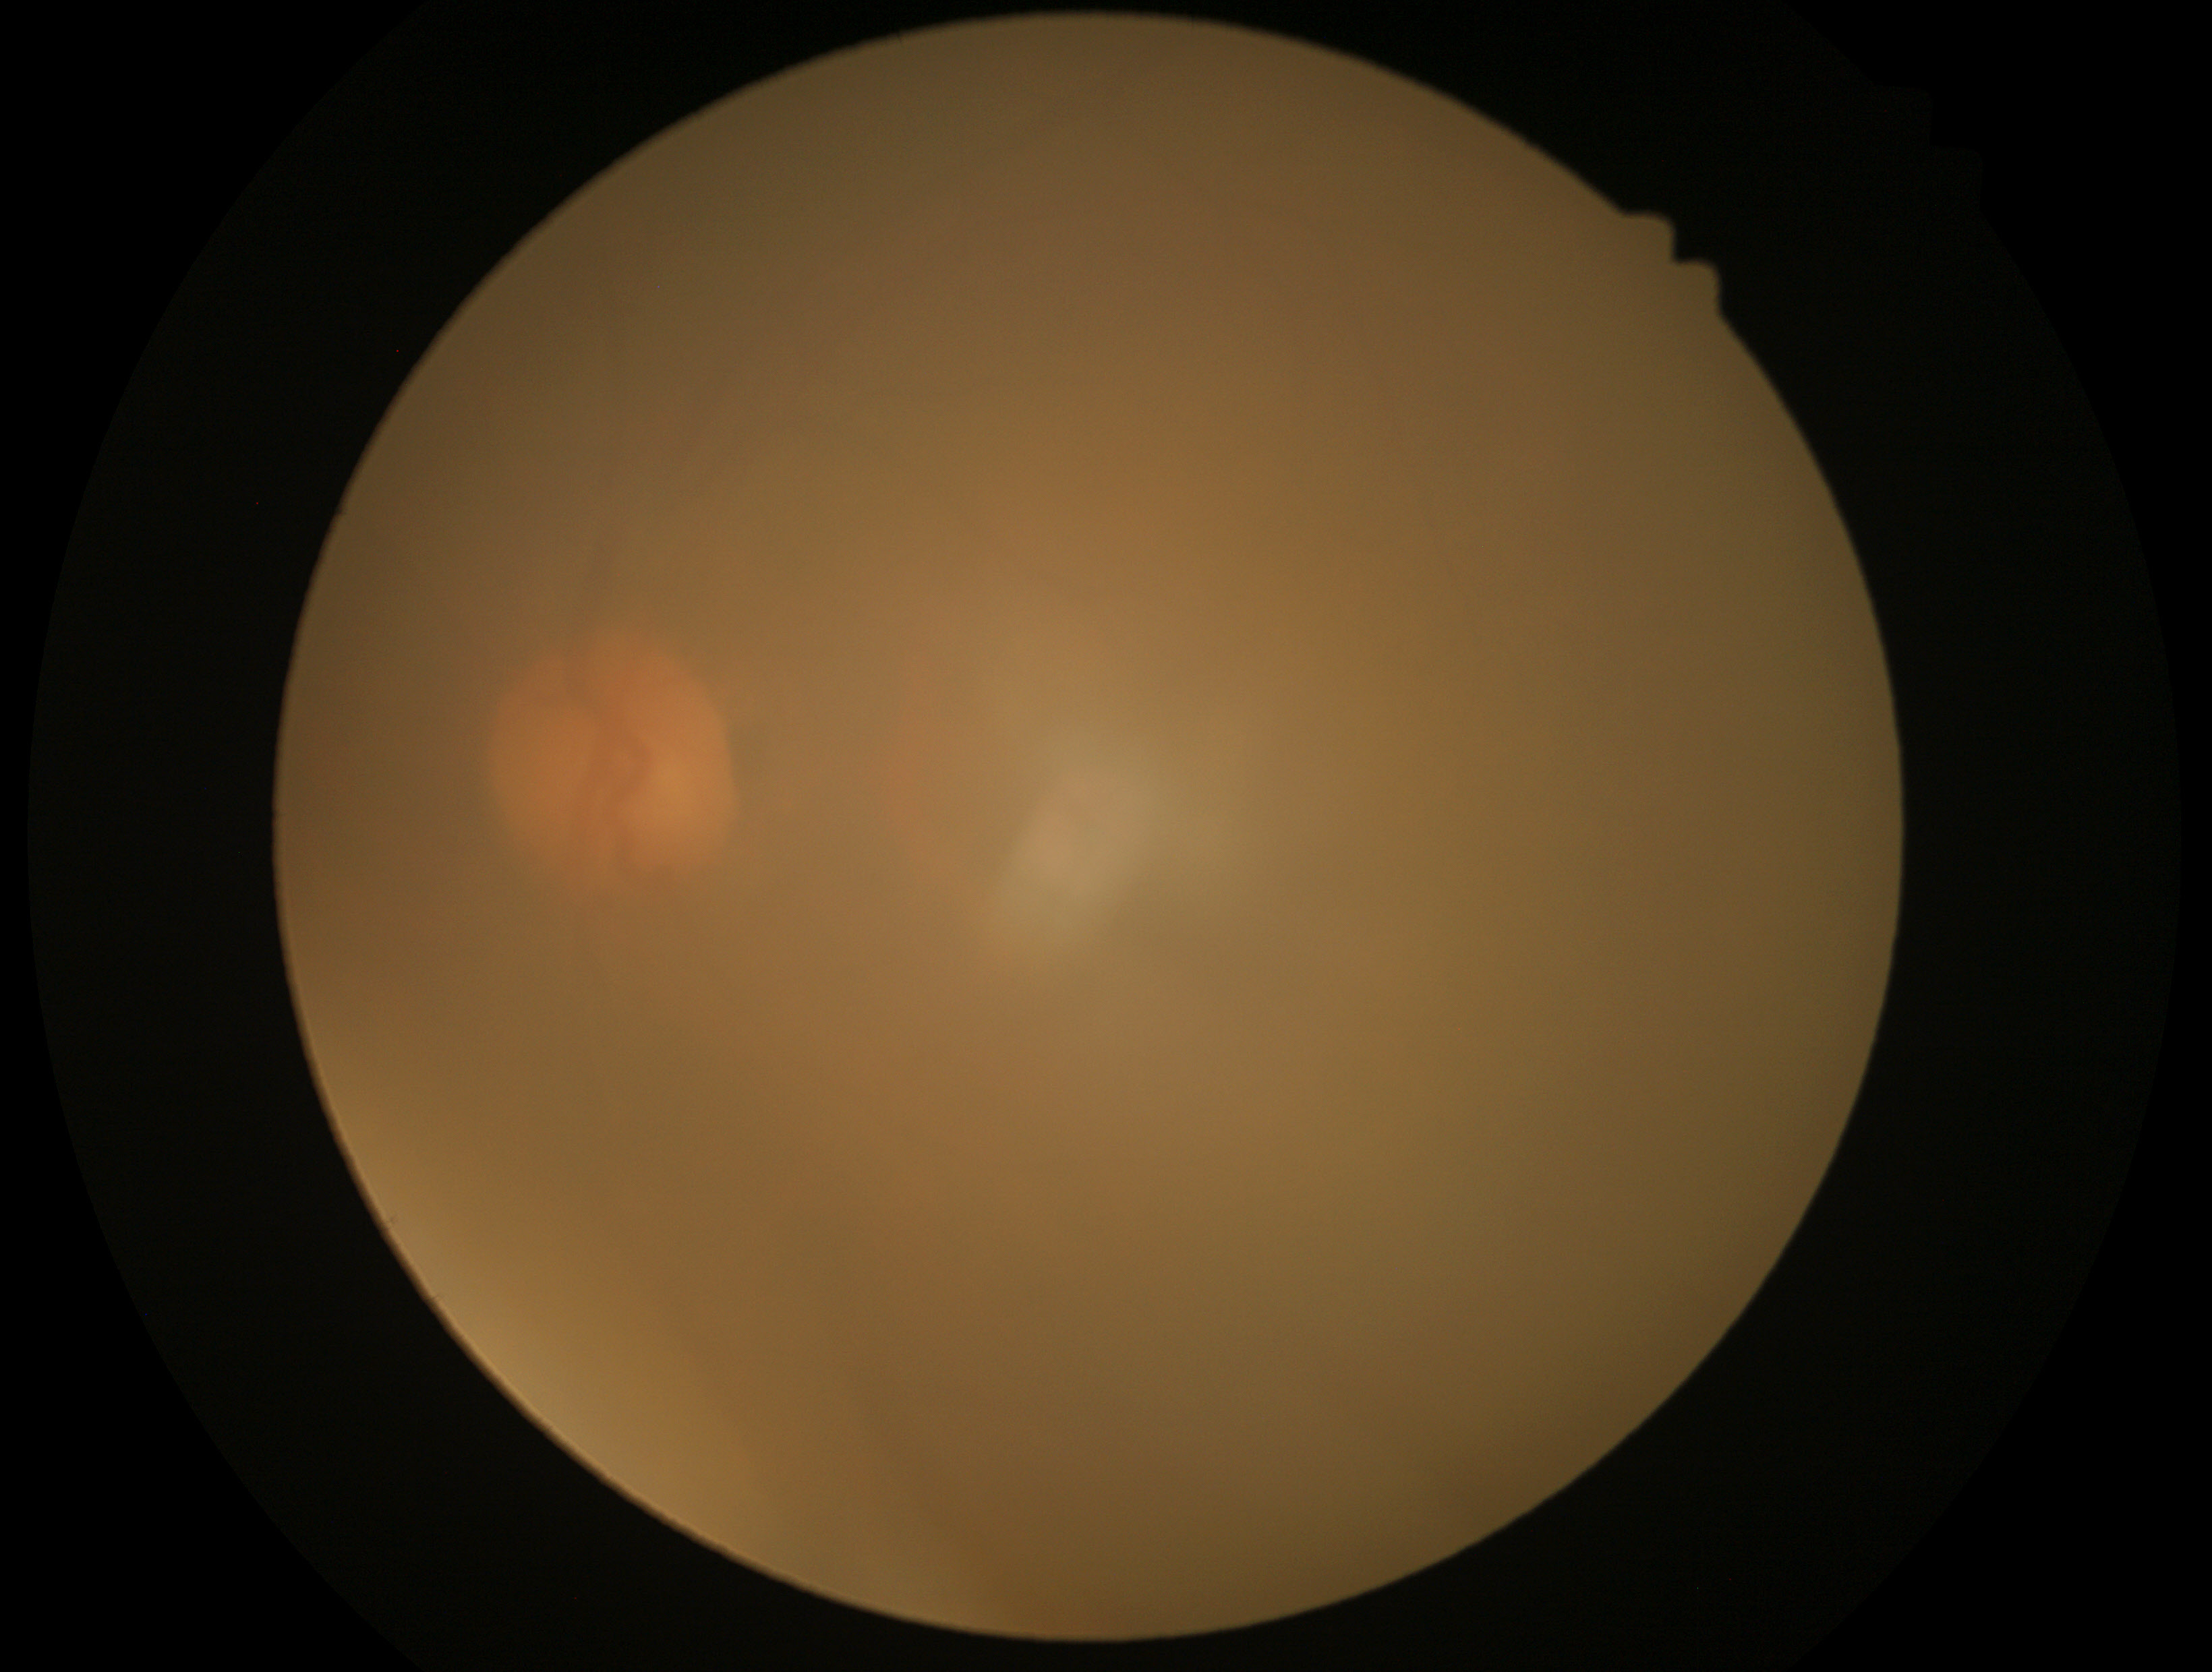
  dr_grade: ungradable due to poor image quality
  quality: below grading threshold